Wide-field fundus photograph of an infant — 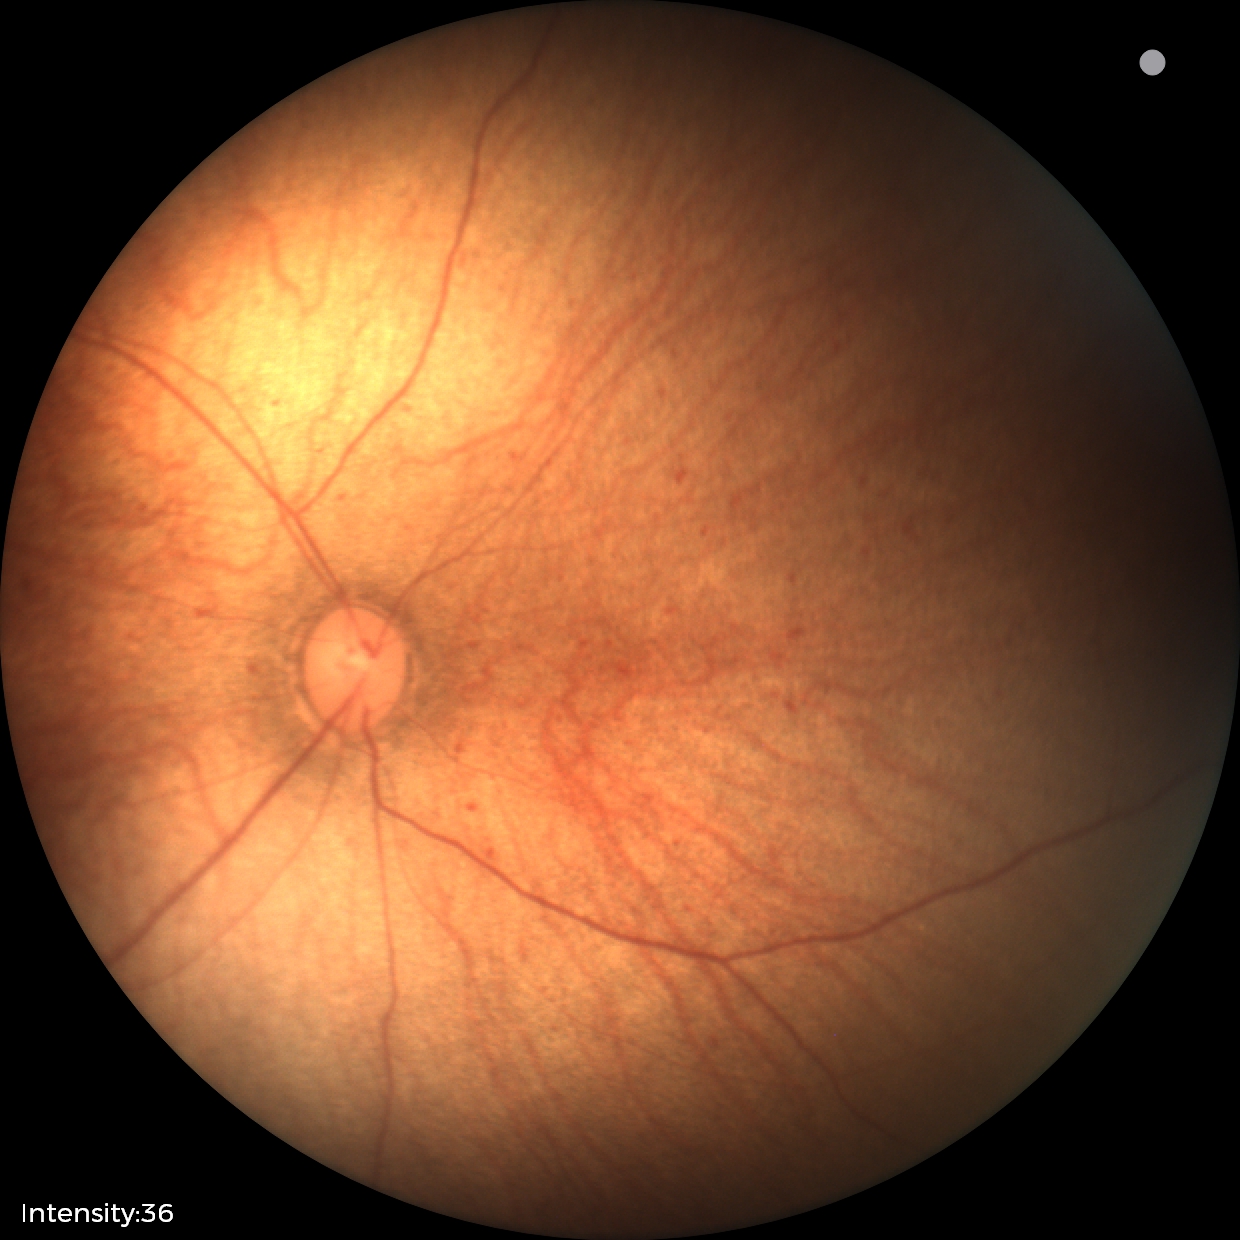

Impression: physiological finding.